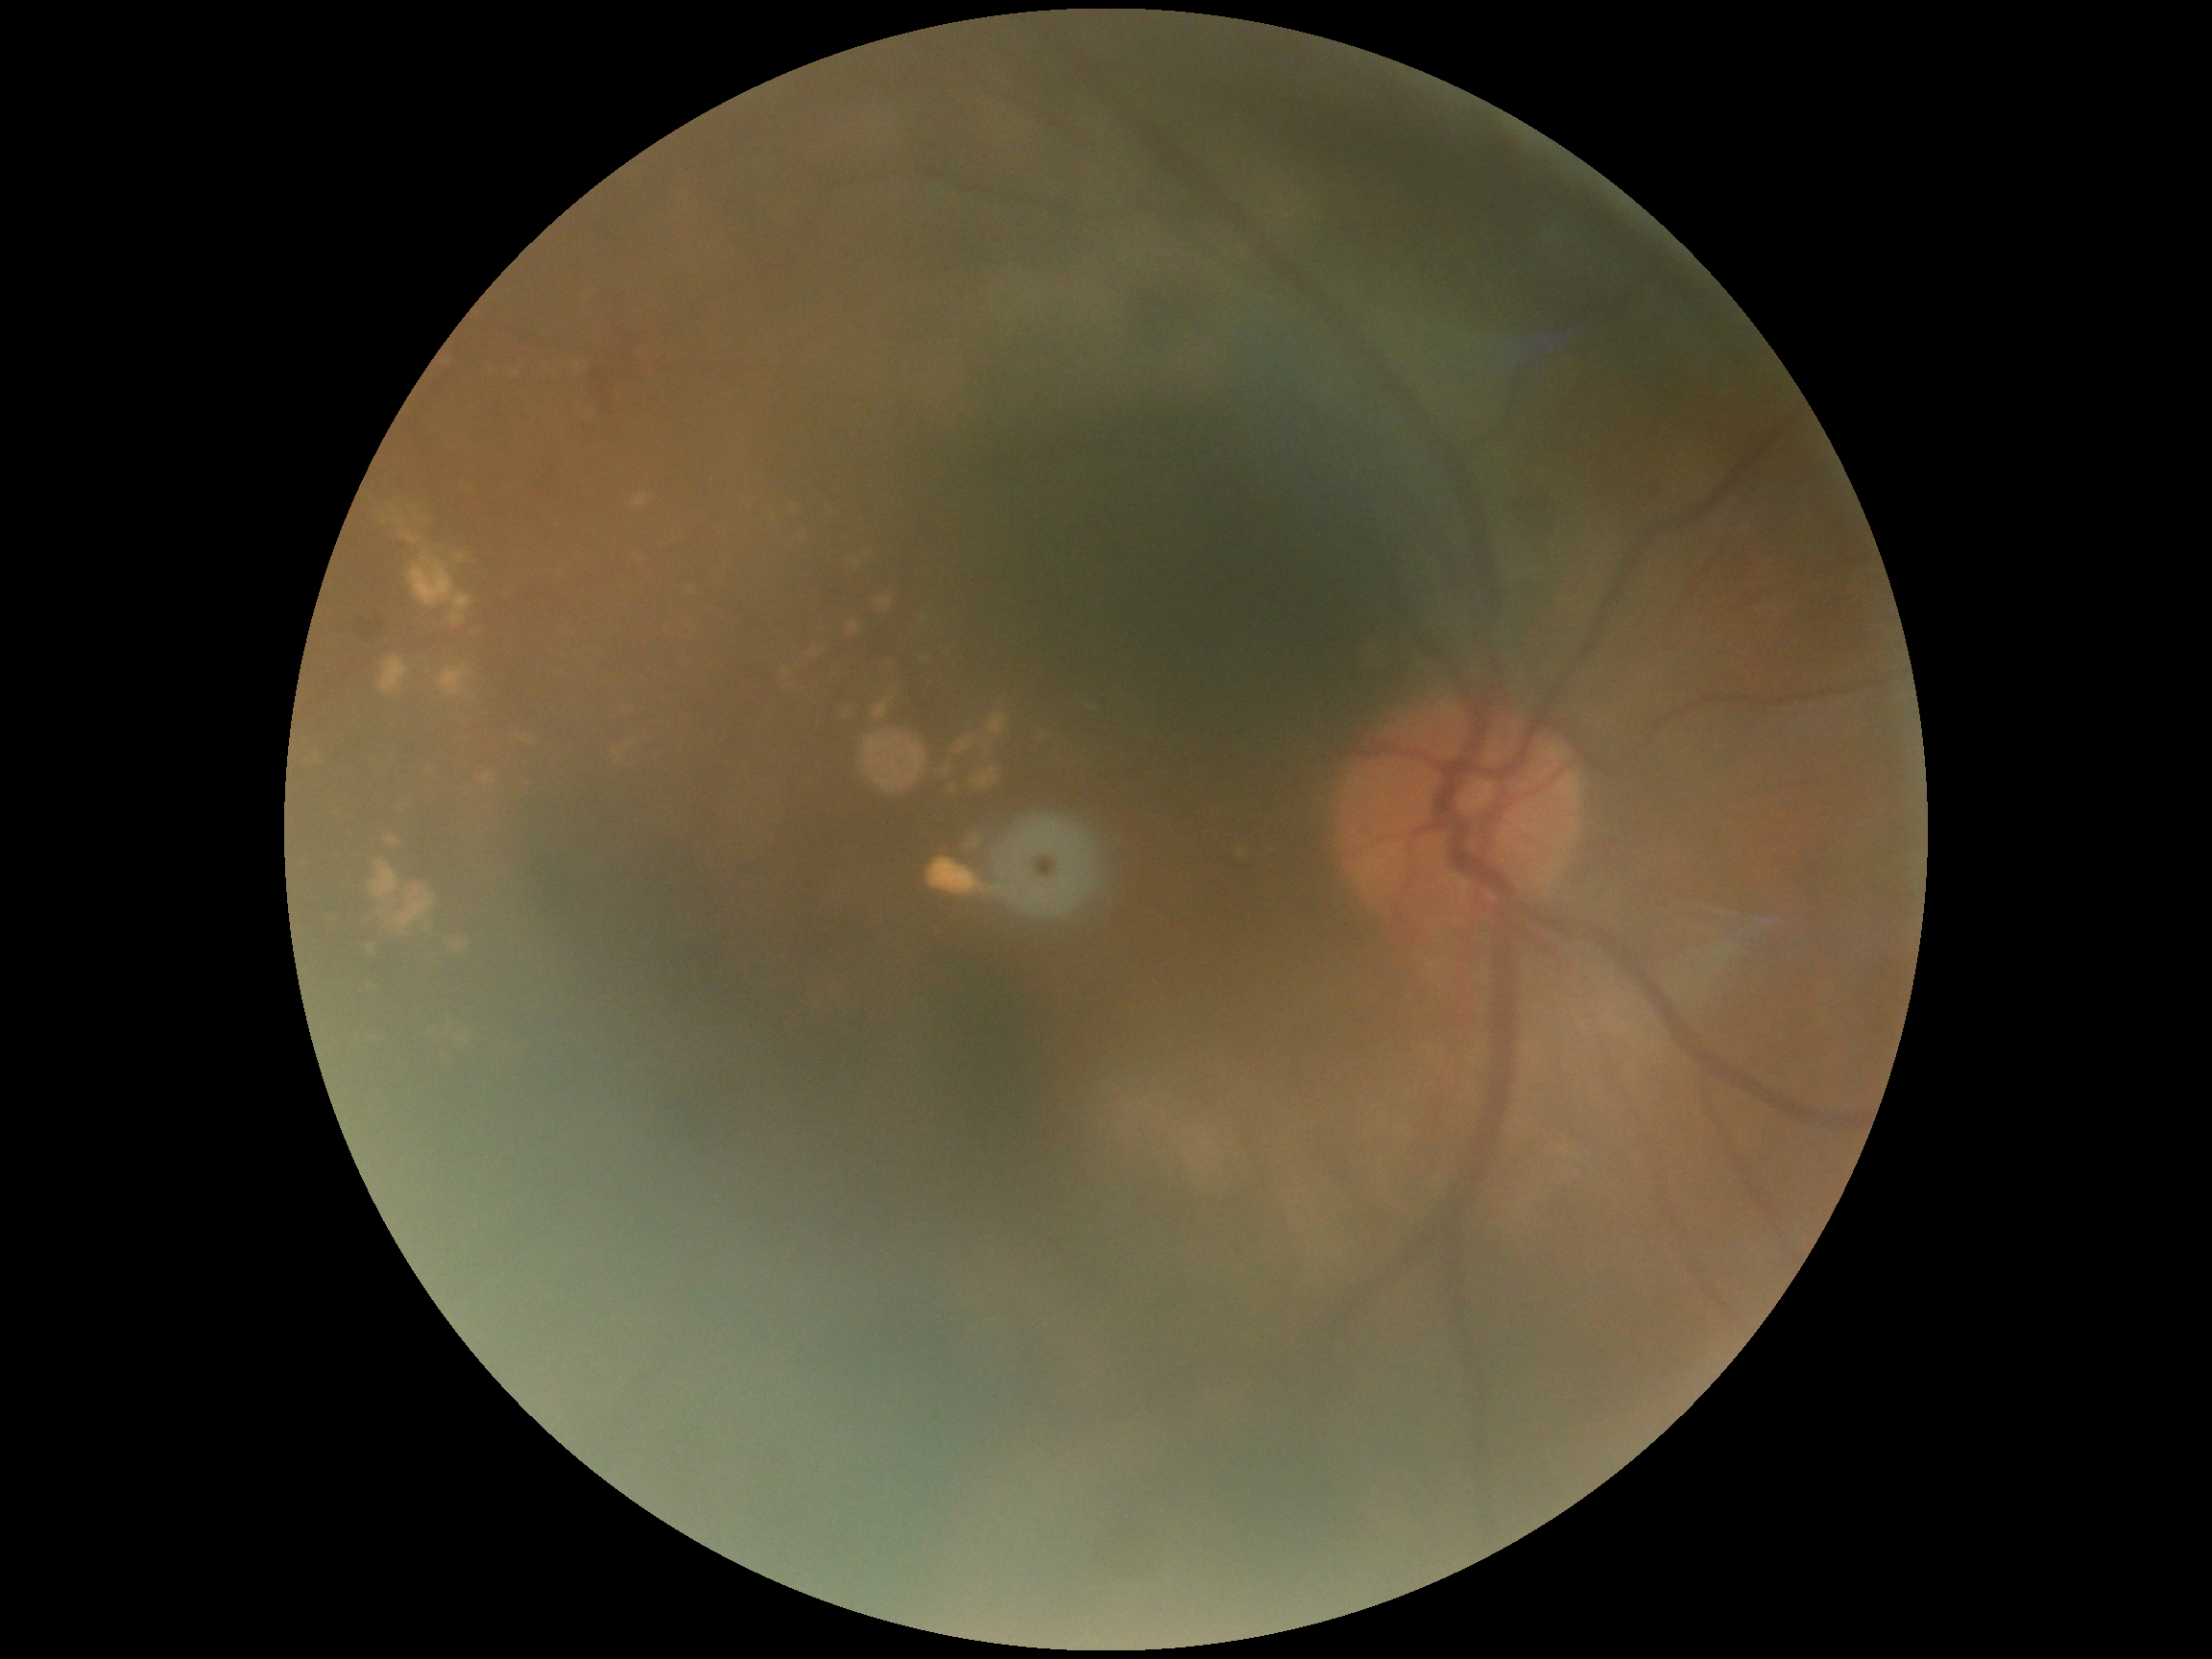

– DR severity: moderate non-proliferative diabetic retinopathy (grade 2)